Color fundus image — 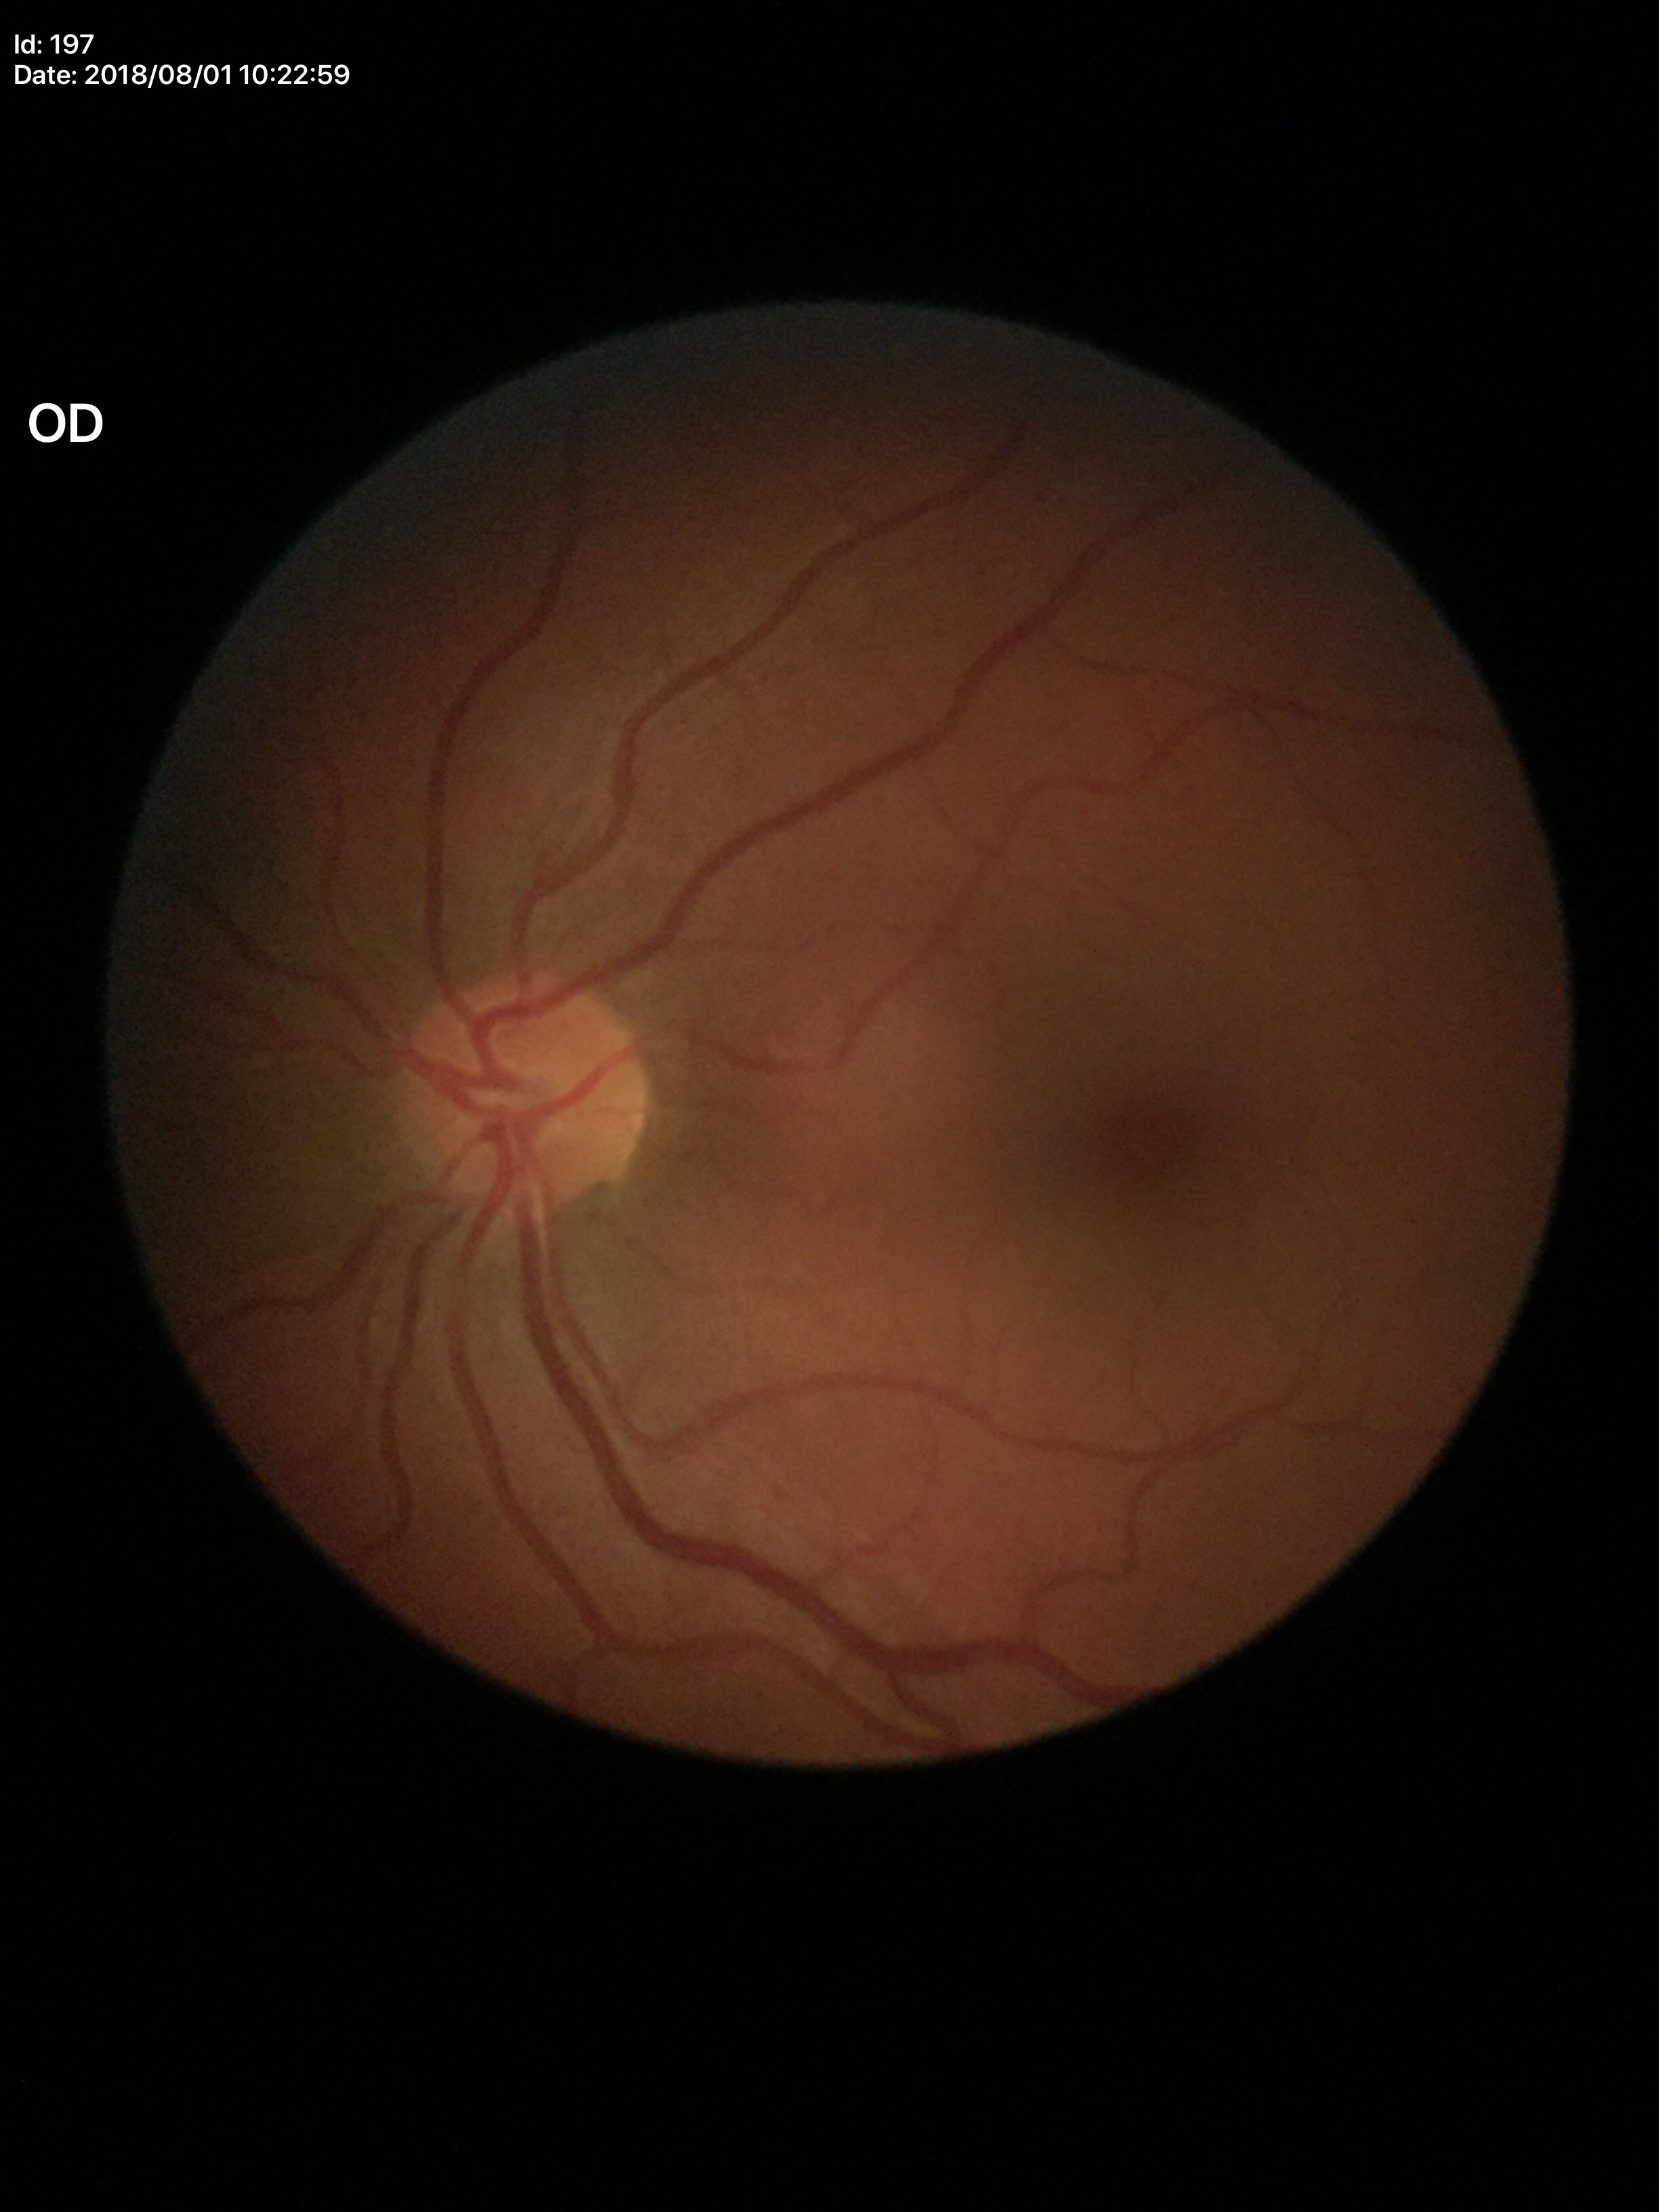
Glaucoma decision: no suspicious findings.
Vertical cup-disc ratio: 0.45.